DR severity per modified Davis staging · 45 degree fundus photograph · 848x848.
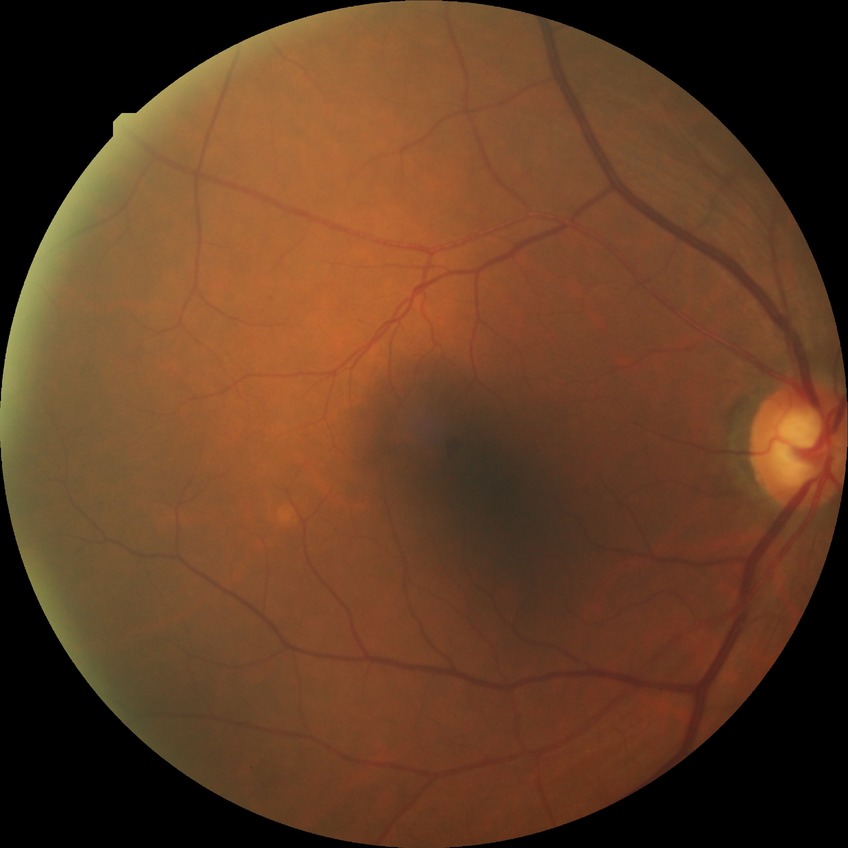 Diabetic retinopathy (DR): SDR (simple diabetic retinopathy).